45° FOV · fundus photo: 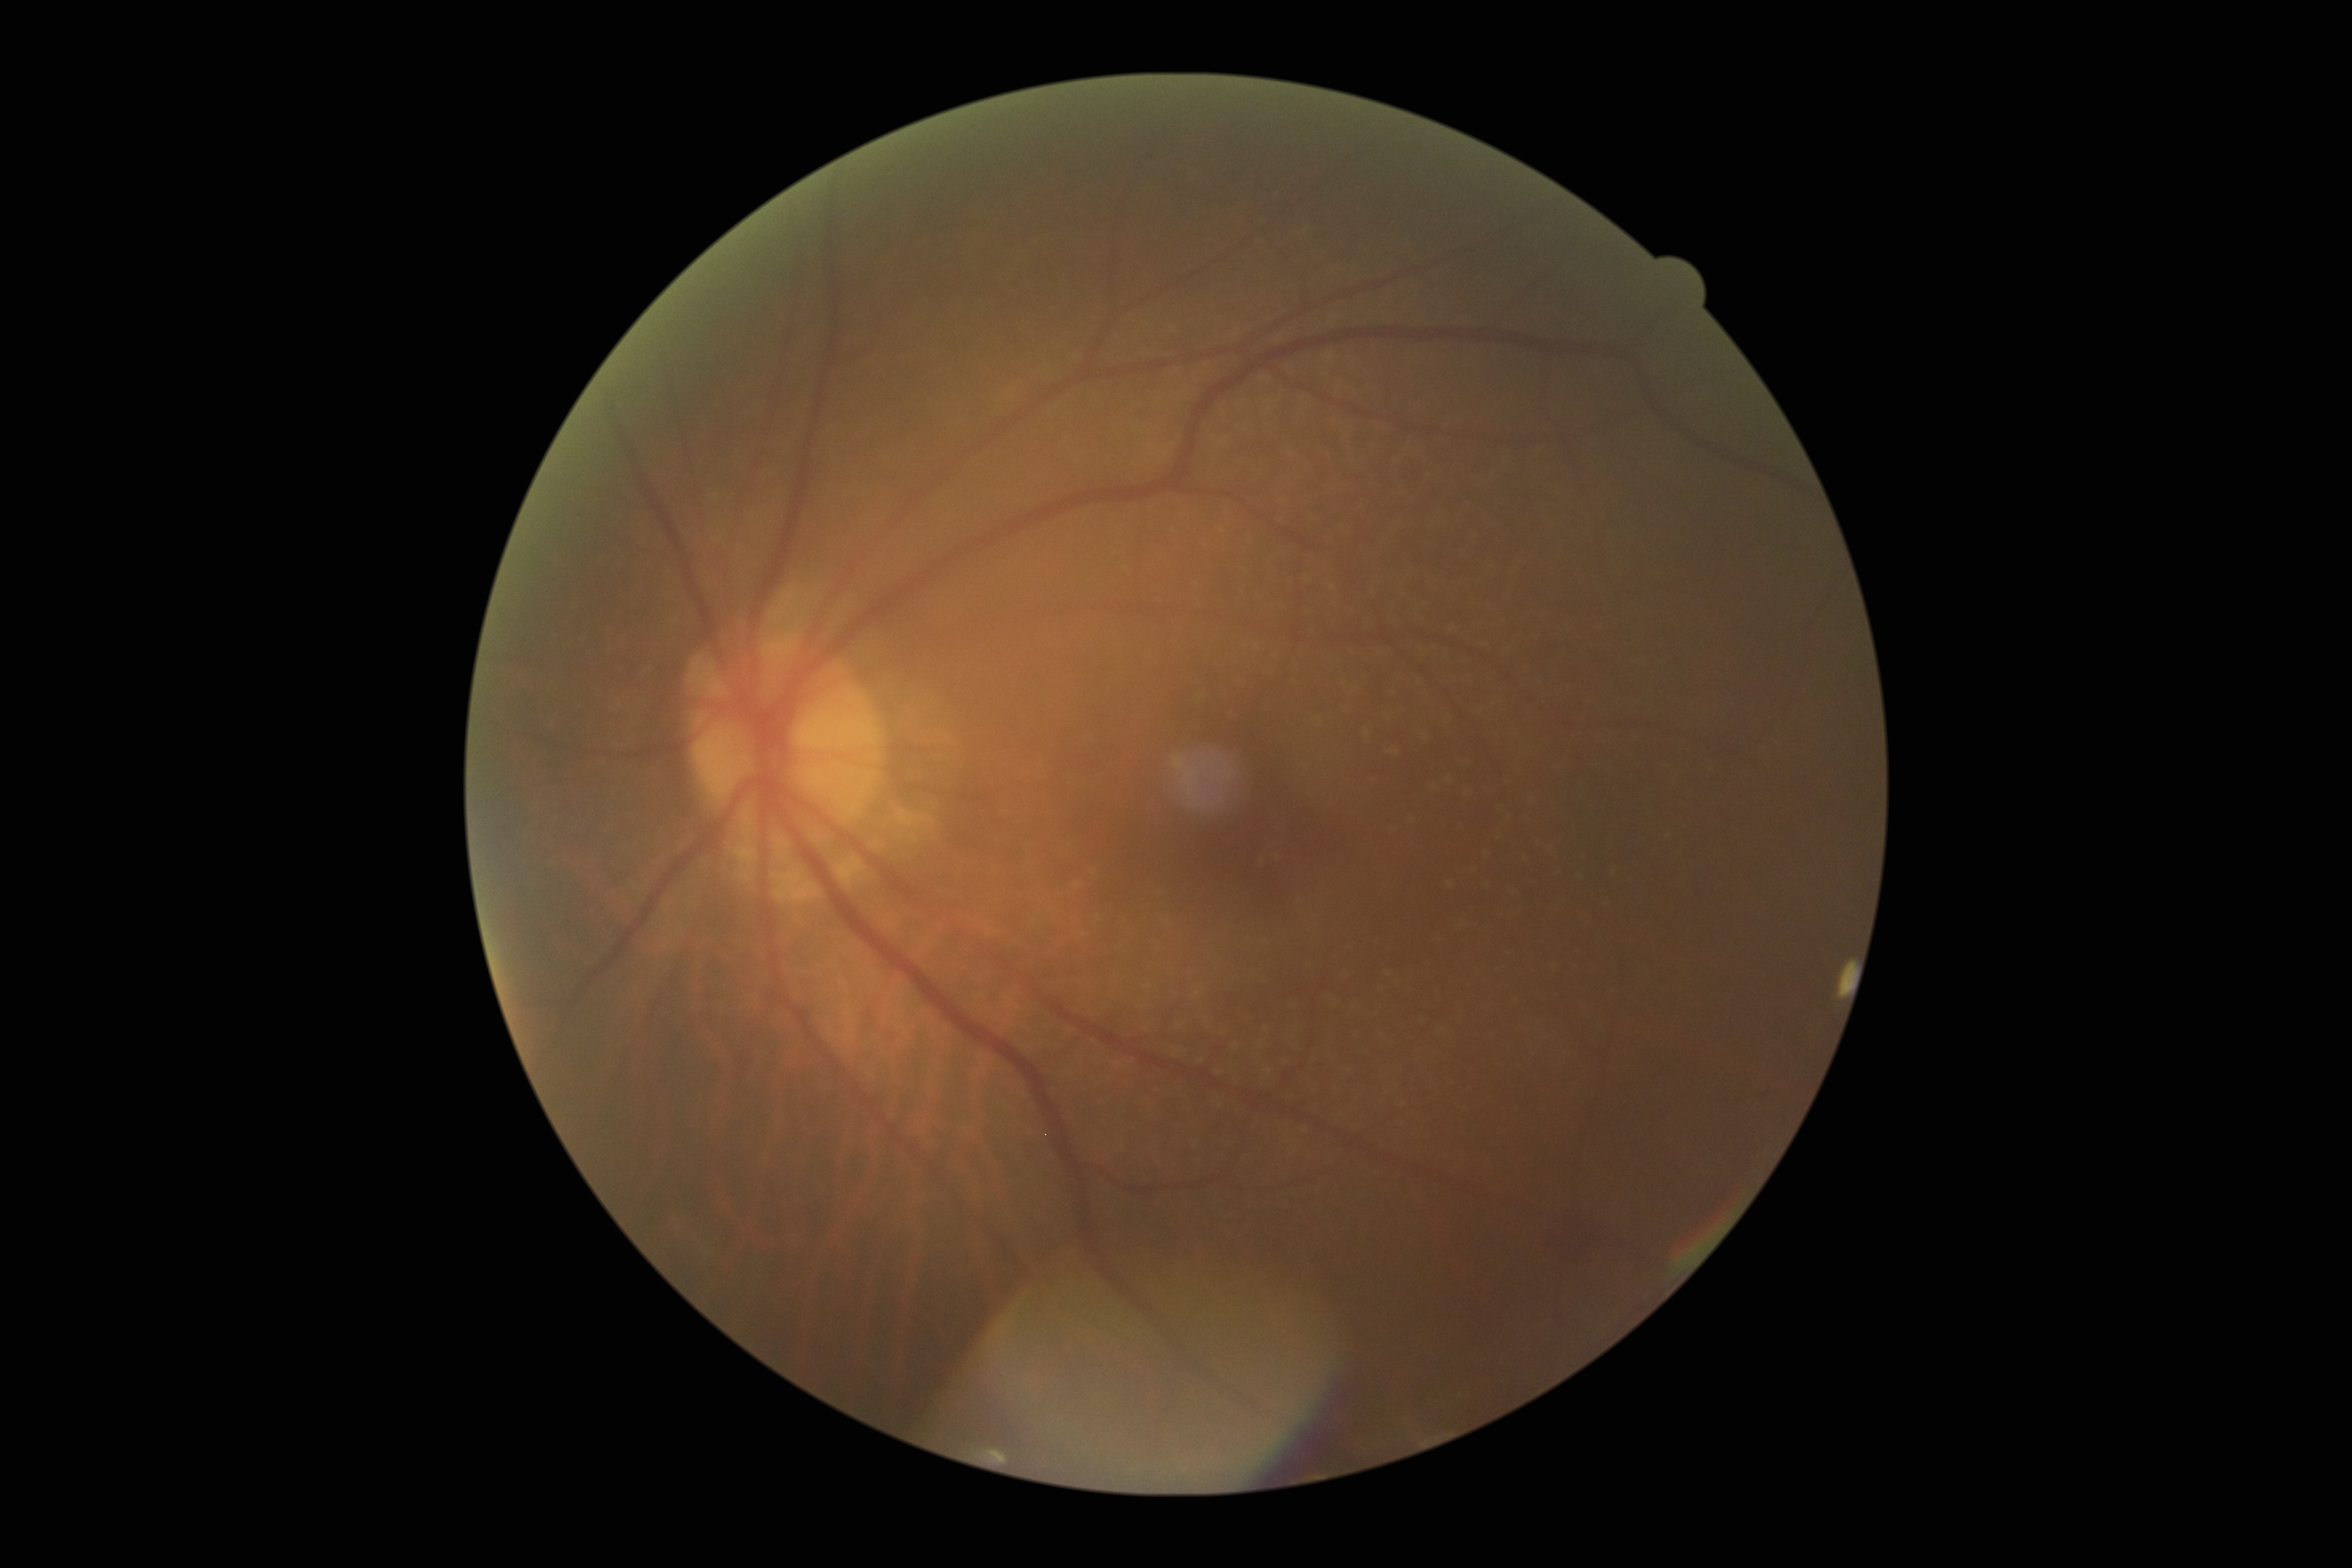

DR is grade 2.